Fundus photo, 512 by 512 pixels — 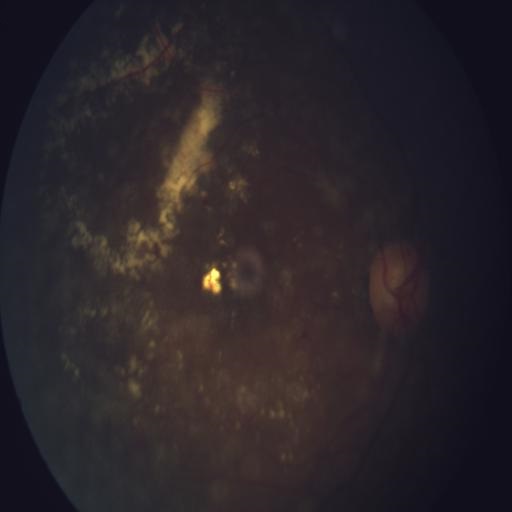
Pathology: asteroid hyalosis (AH).